FOV: 45 degrees. Color fundus photograph. NIDEK AFC-230 fundus camera.
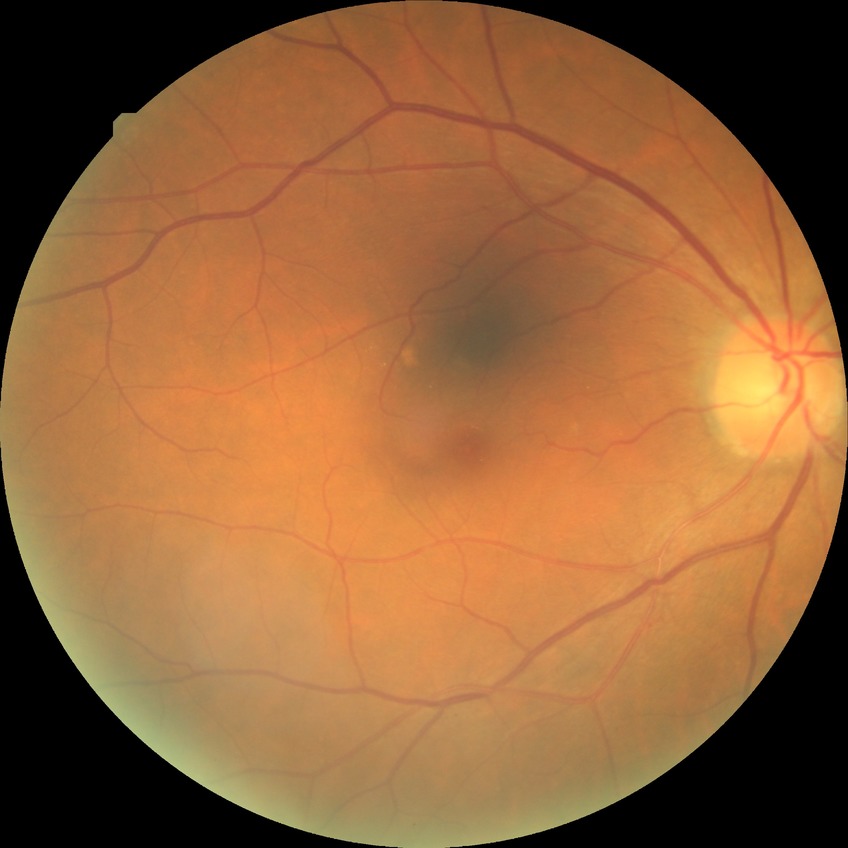 Assessment:
- diabetic retinopathy (DR) — no diabetic retinopathy (NDR)